2212 x 1659 pixels
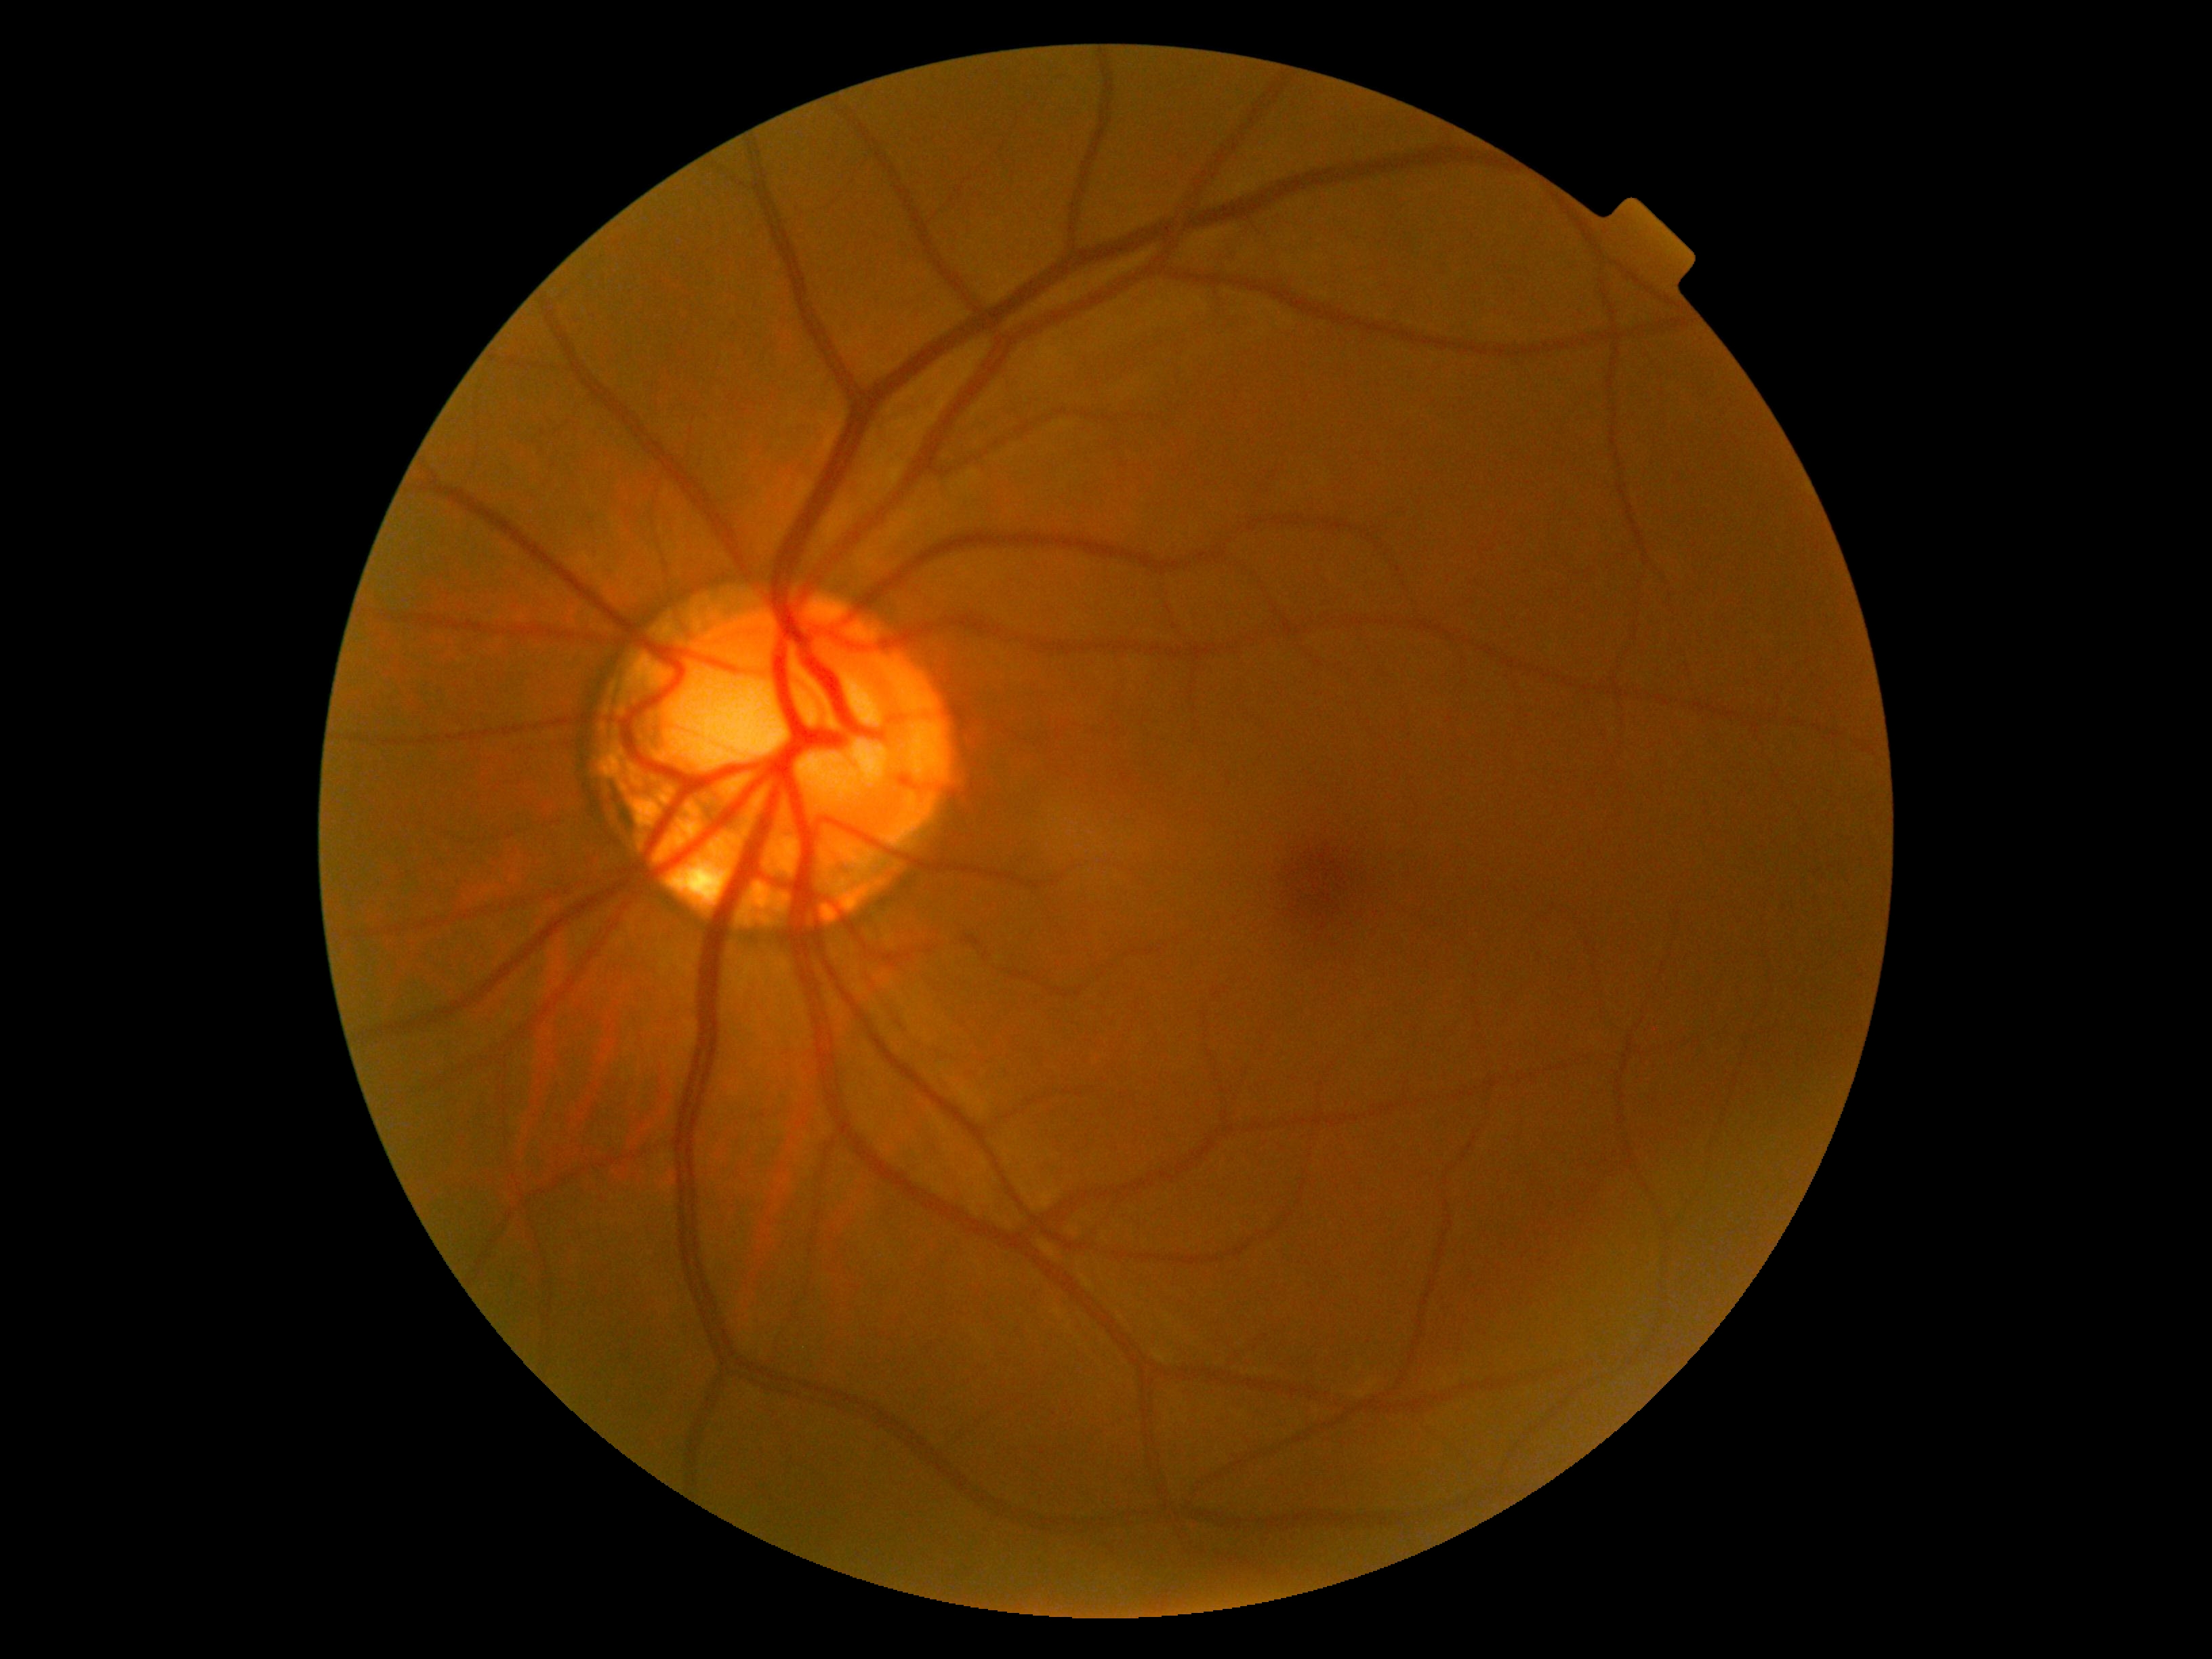 {
  "dr_grade": "0 — no visible signs of diabetic retinopathy"
}